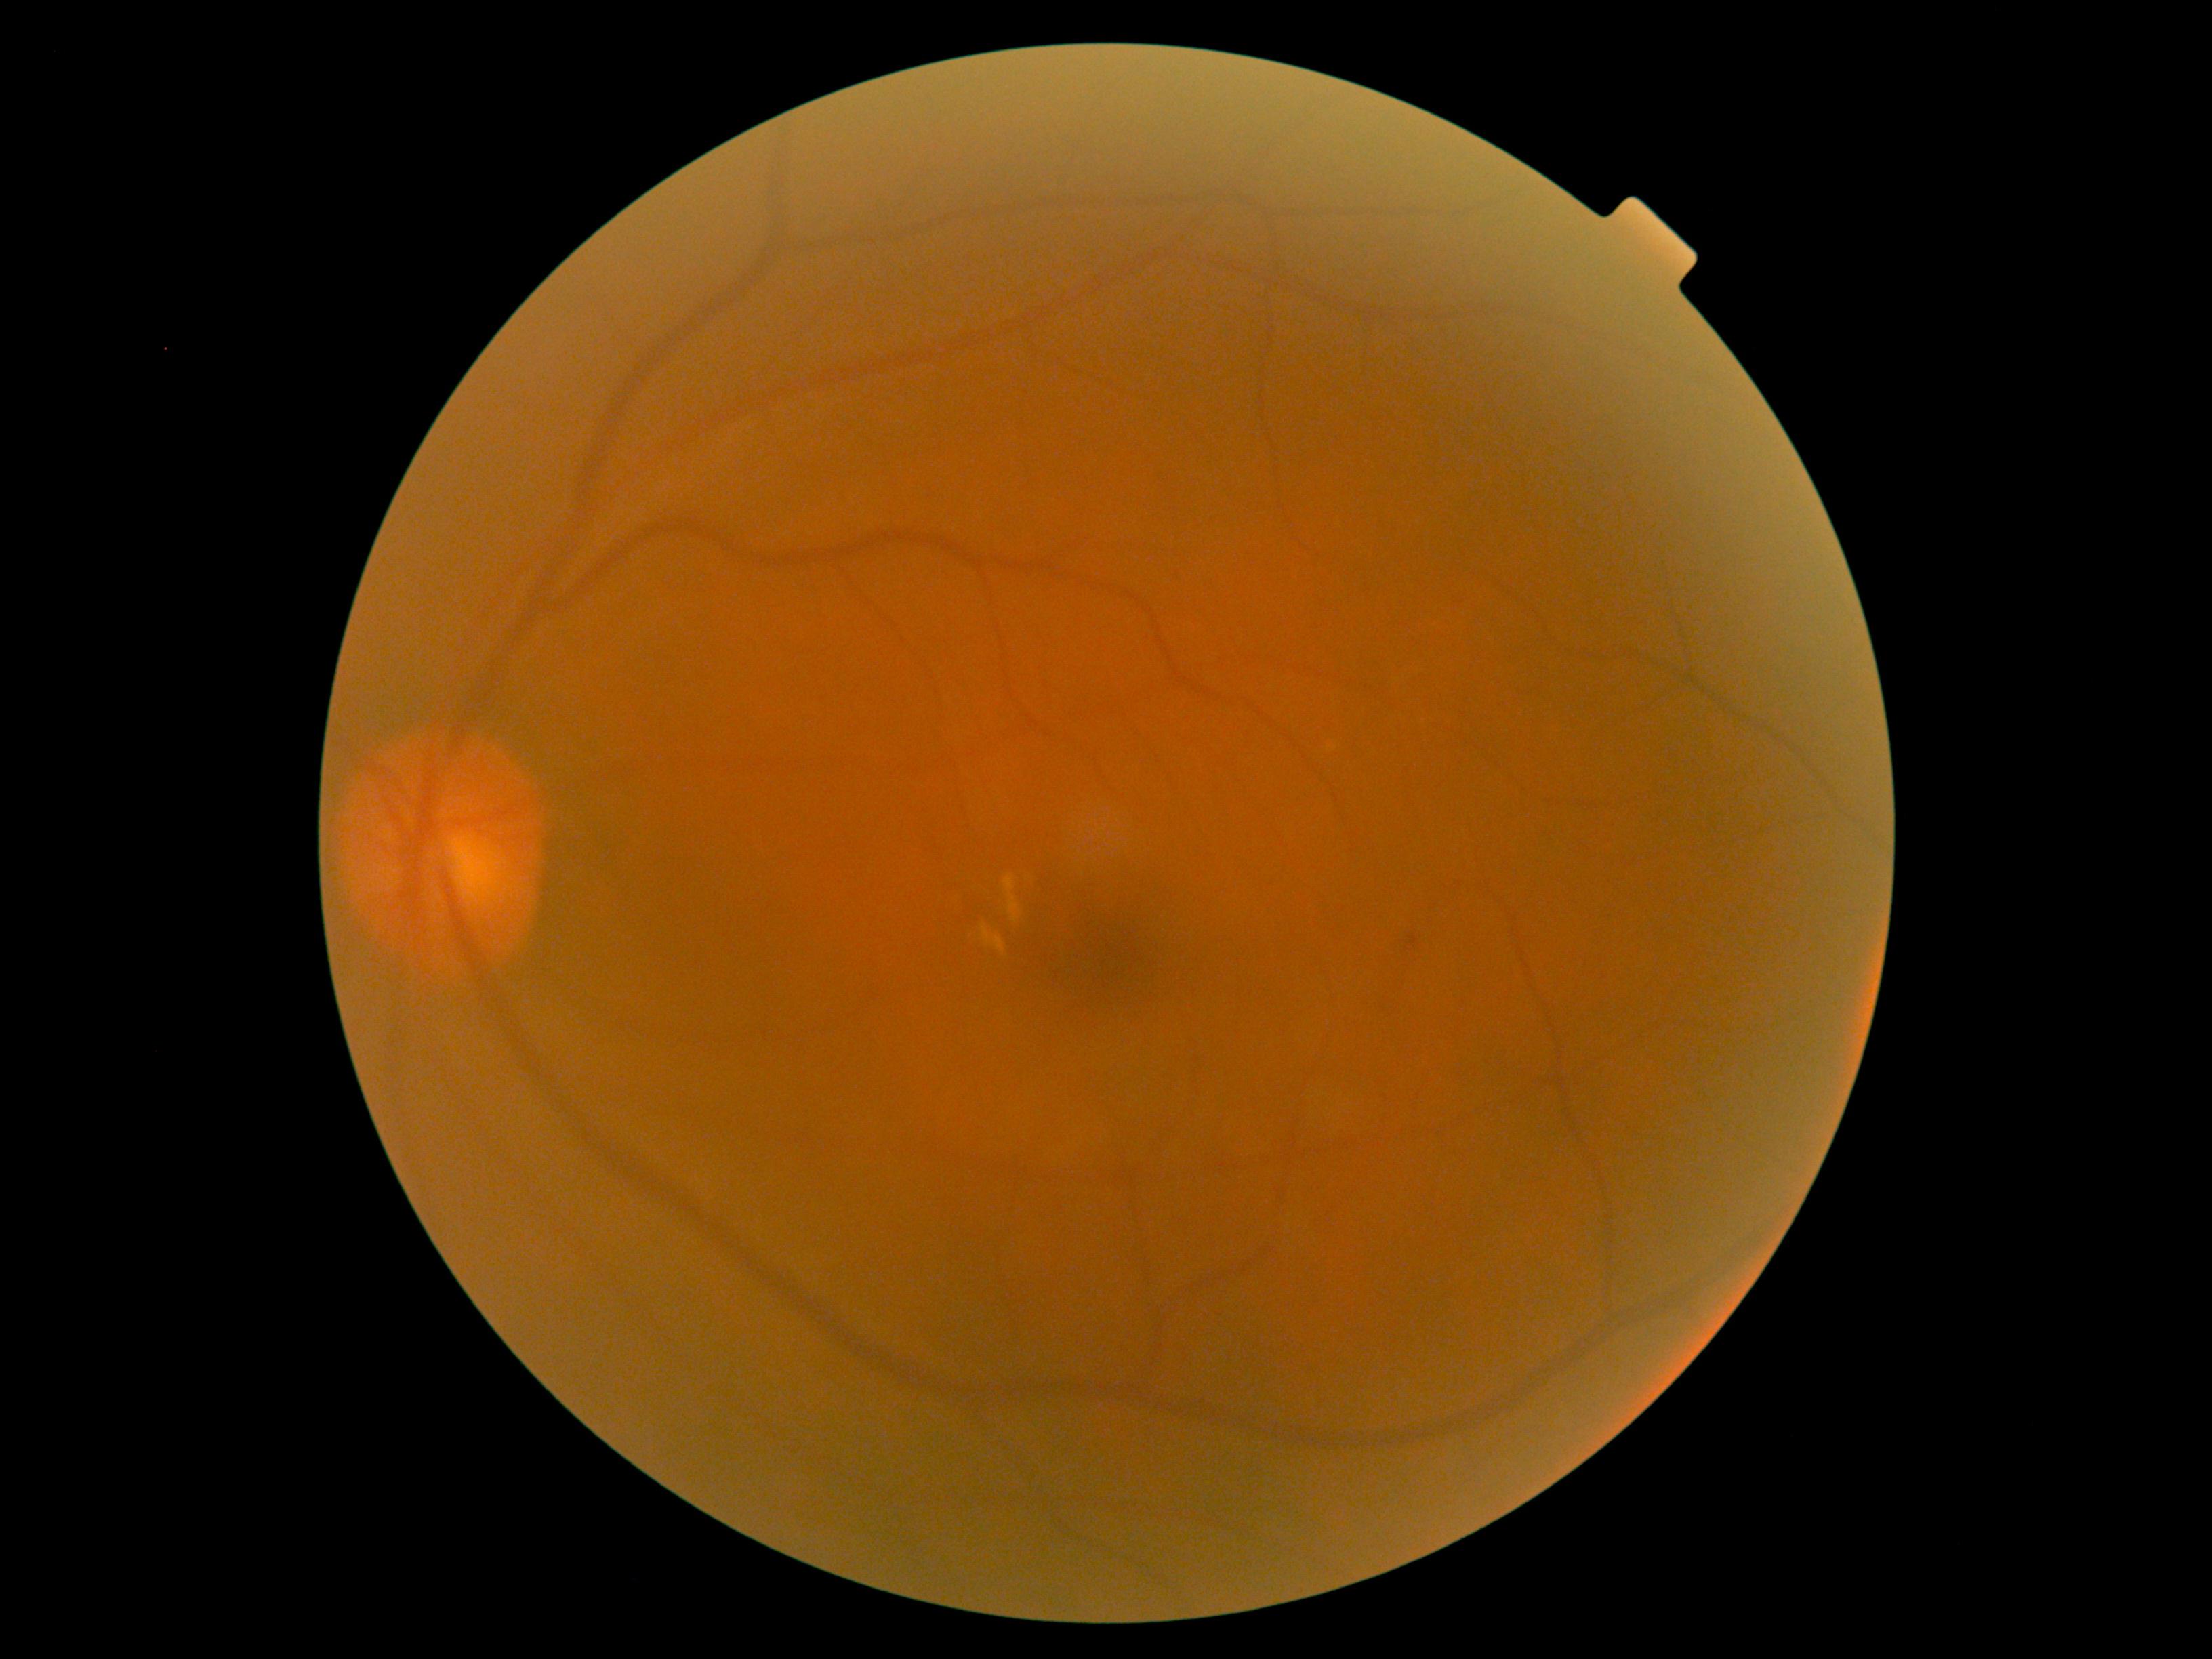
{
  "dr_grade": "grade 2 (moderate NPDR)",
  "dr_category": "non-proliferative diabetic retinopathy"
}